Fundus photo · 50° field of view — 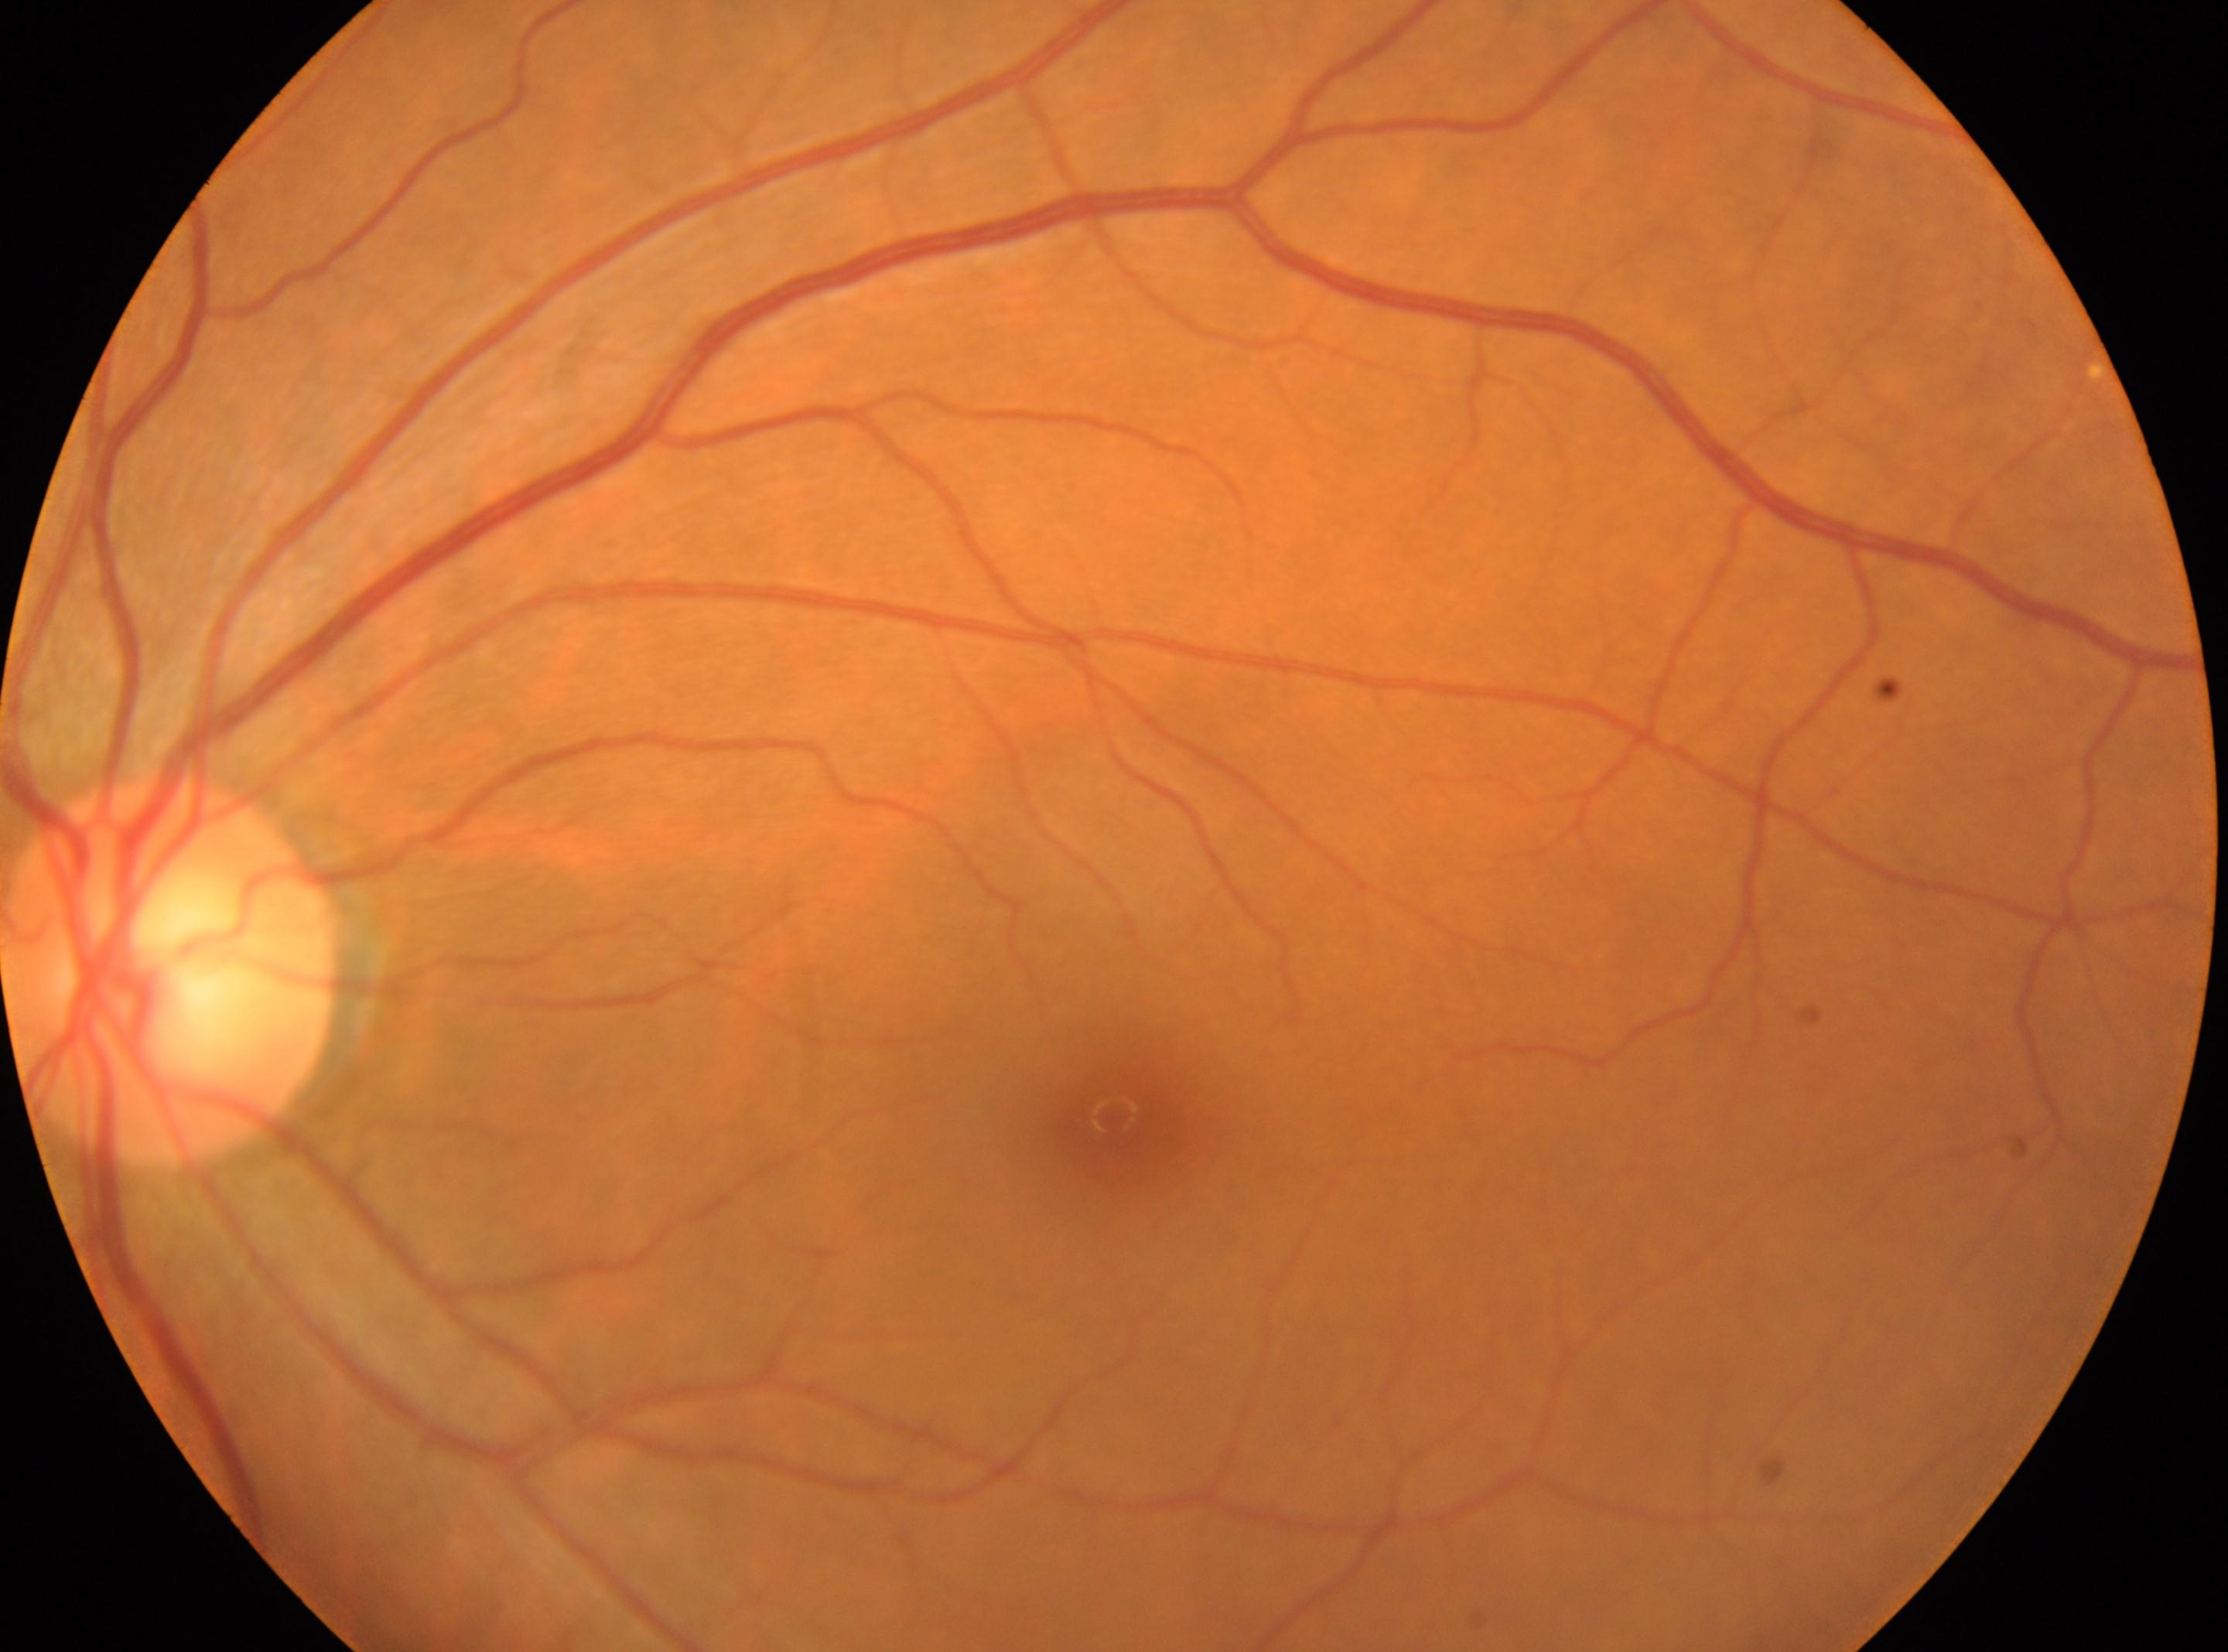
Retinopathy is 0 — no visible signs of diabetic retinopathy. The image shows the OS. Disc center: 171, 971. No apparent diabetic retinopathy. Macular center: 1111, 1115.